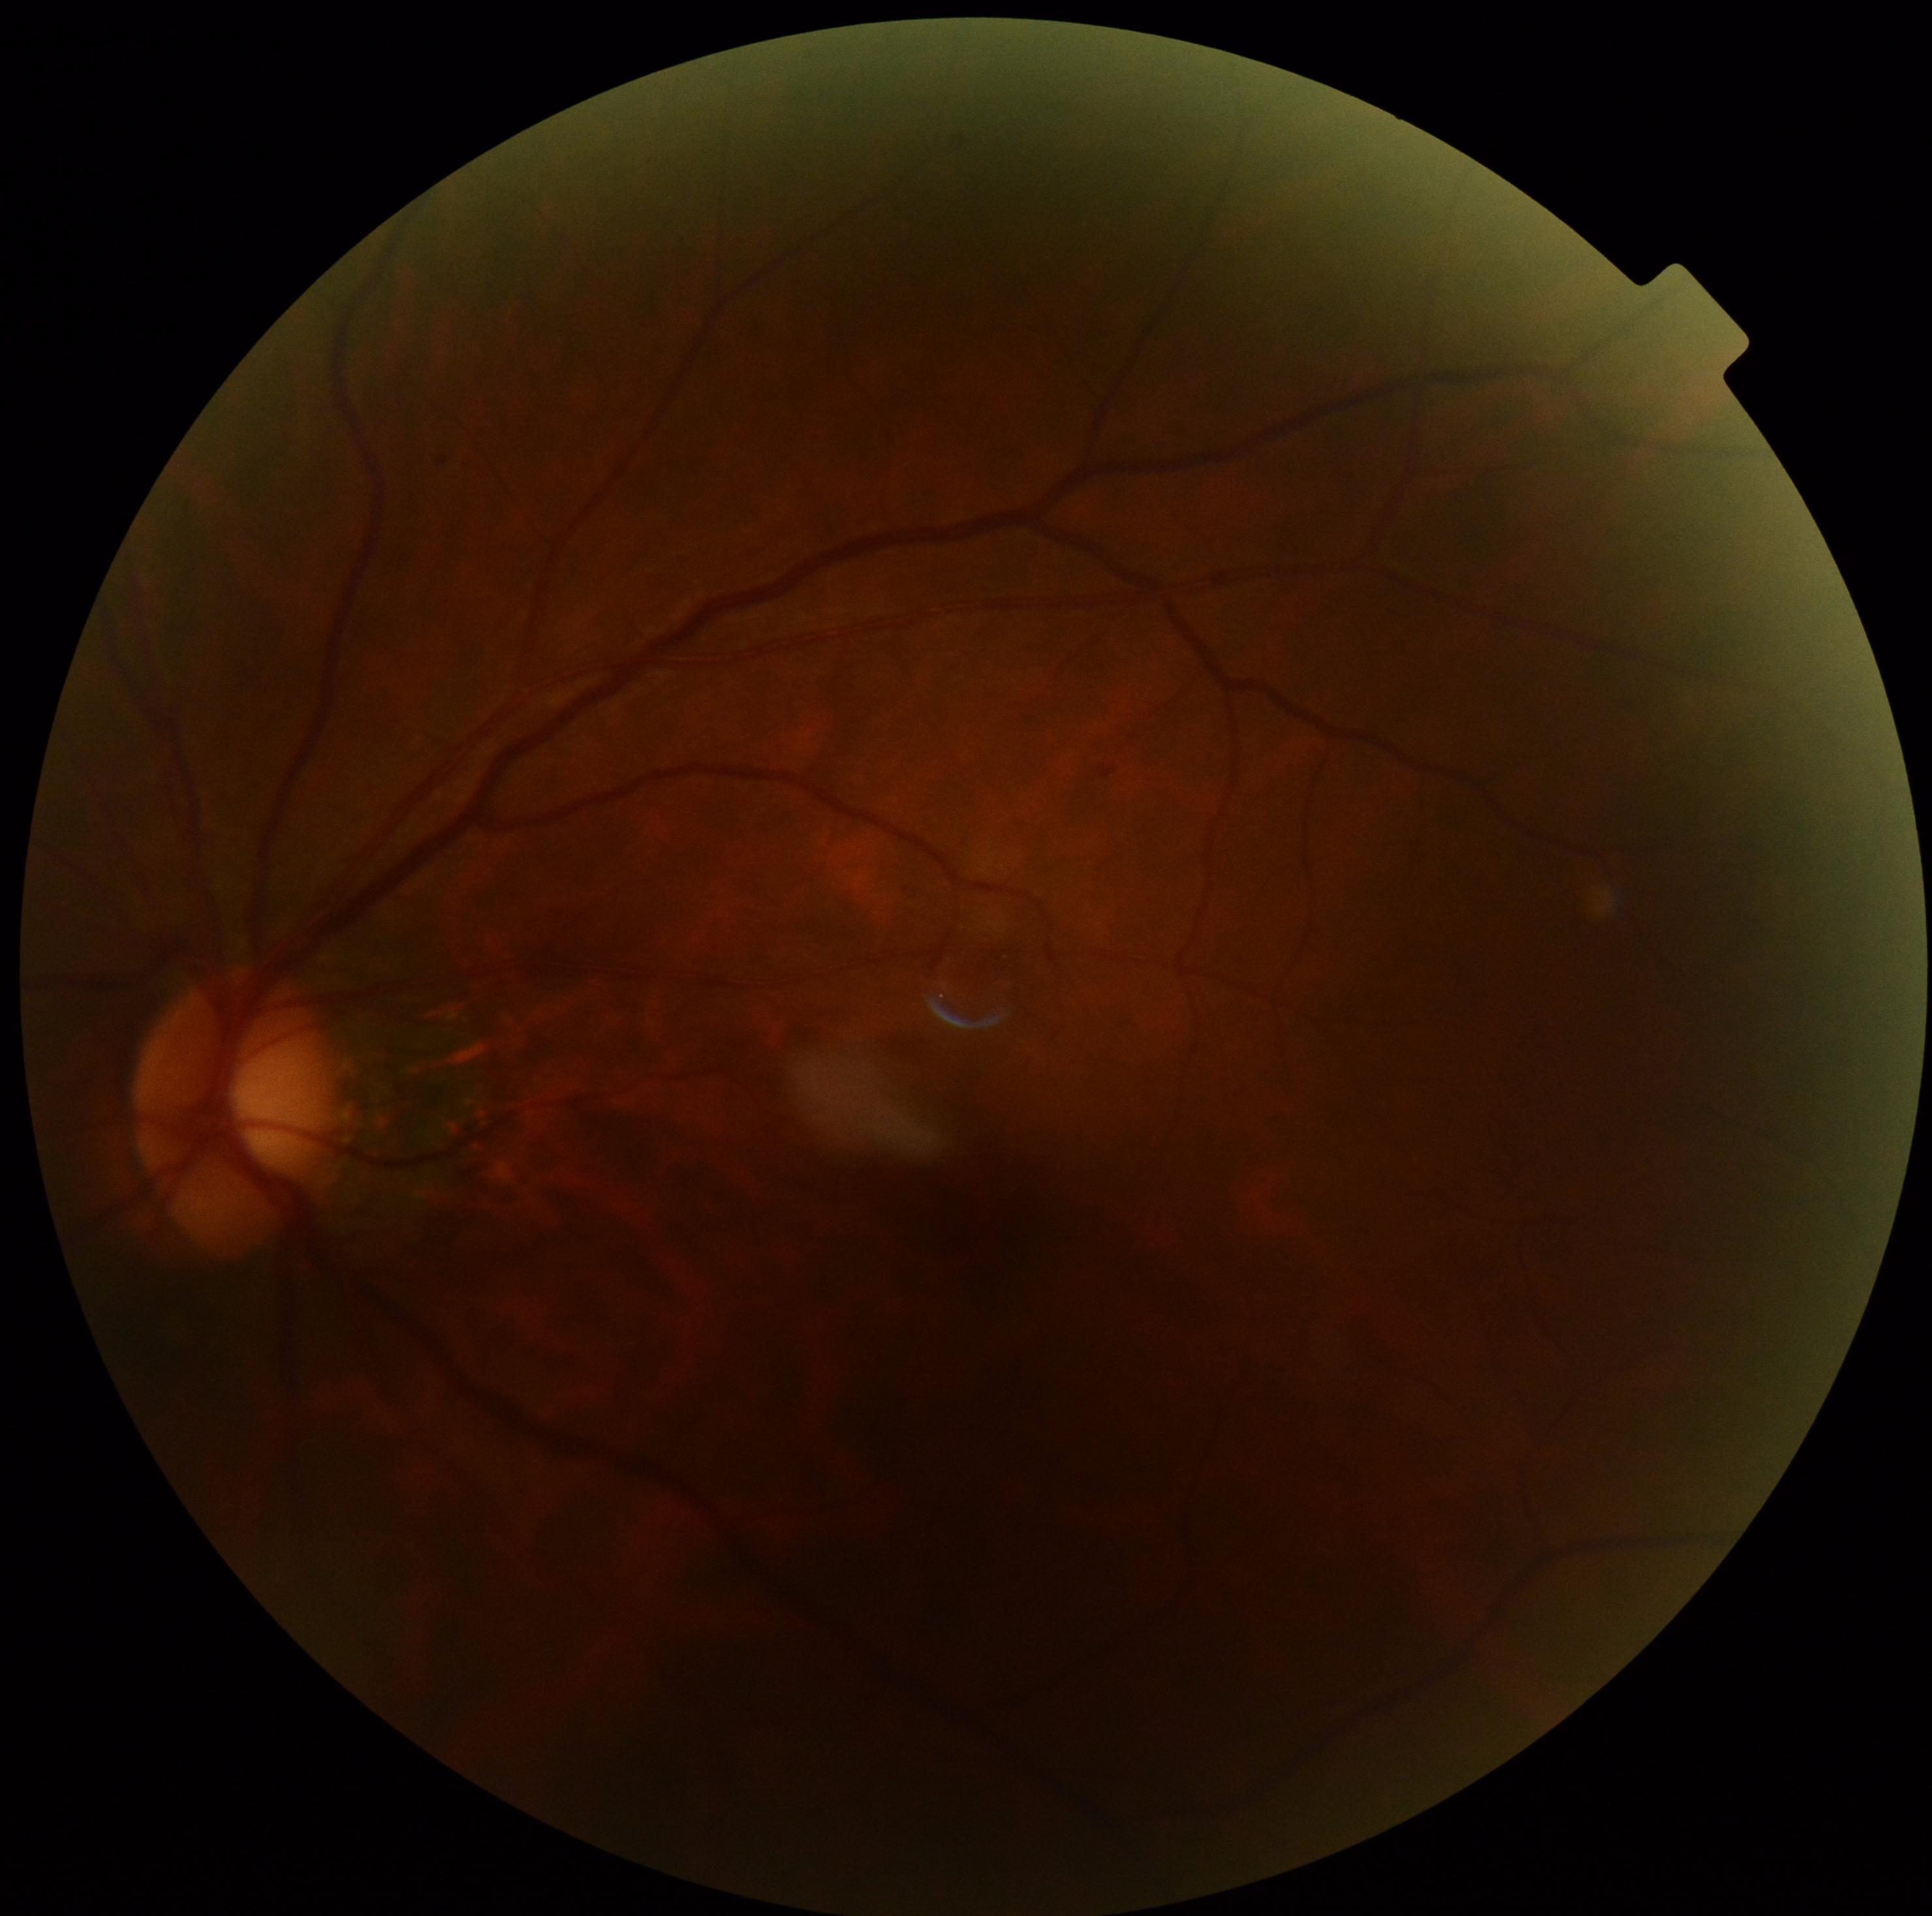 DR grade: 0.